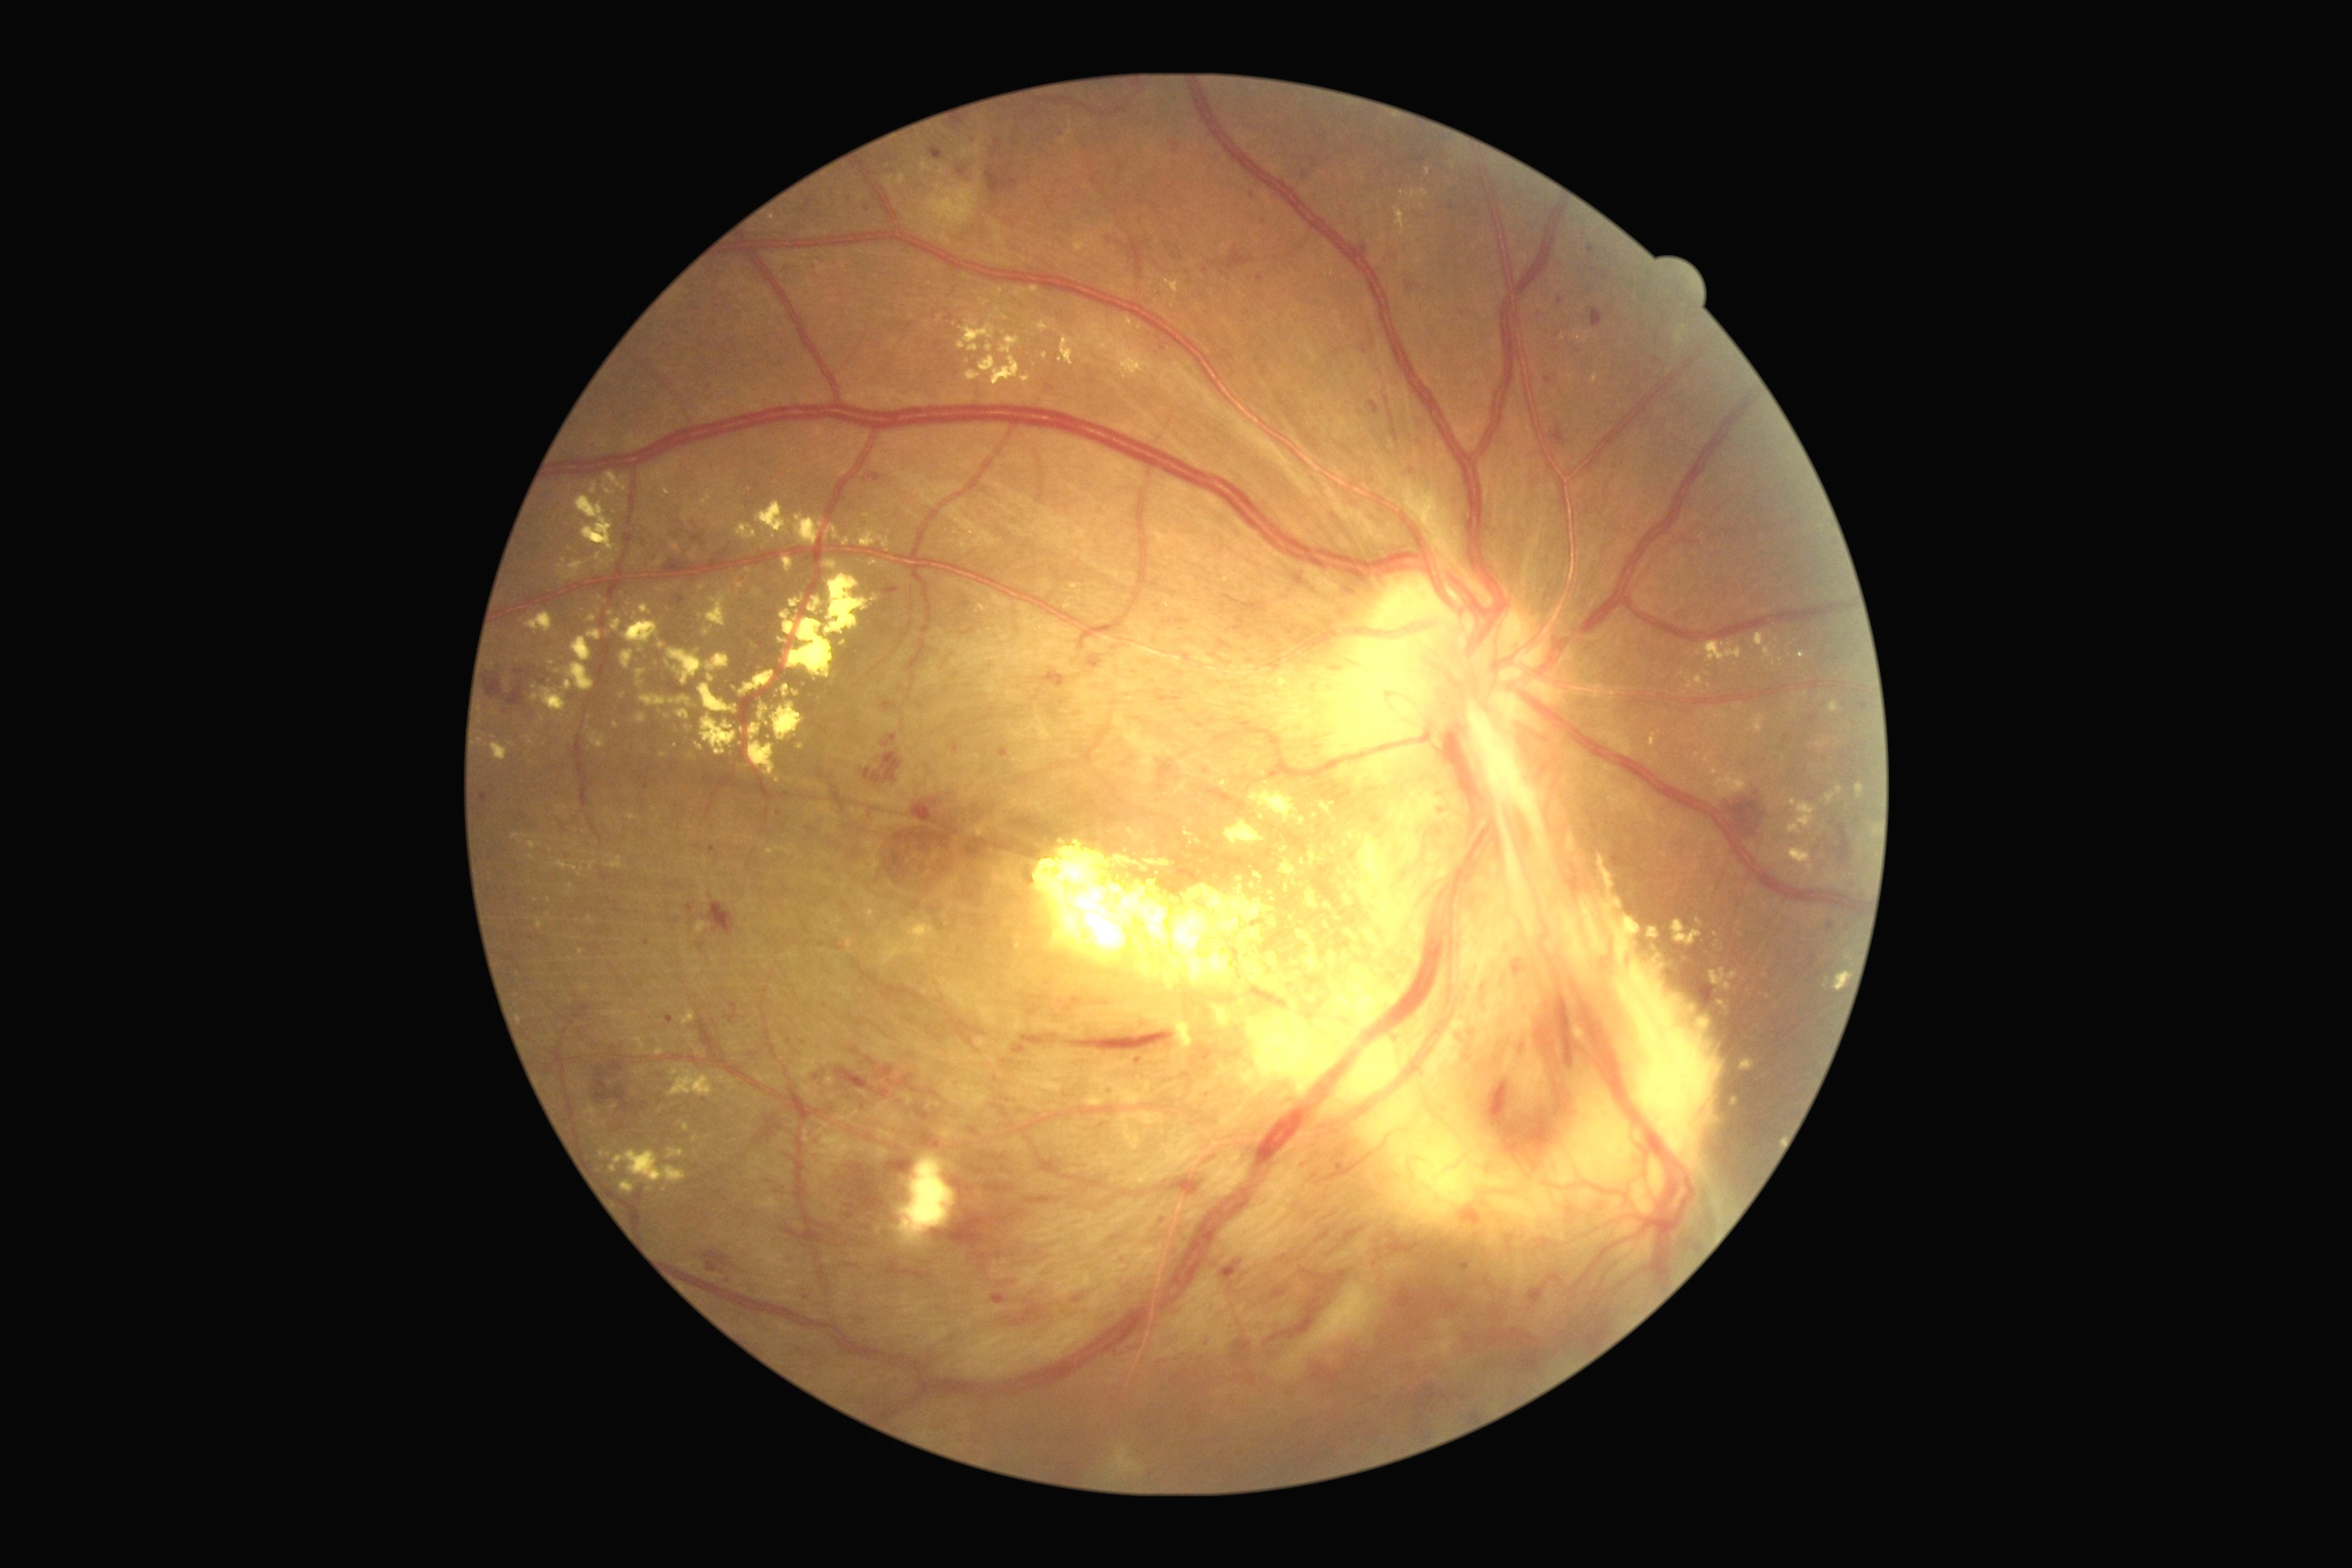

<lesions partial="true">
  <dr_grade>4</dr_grade>
  <ex partial="true">[701, 716, 738, 756], [640, 694, 667, 707], [1146, 861, 1171, 867], [897, 1153, 957, 1246], [1268, 954, 1279, 968], [1834, 972, 1848, 992], [1754, 716, 1765, 734], [554, 861, 583, 877], [1788, 799, 1816, 836], [1591, 375, 1600, 384], [997, 288, 1004, 297], [1694, 752, 1701, 760], [977, 603, 988, 612], [612, 723, 620, 729]</ex>
  <ex_small>x=768 y=725, x=1346 y=898, x=1271 y=894, x=1045 y=356, x=622 y=697</ex_small>
  <he partial="true">[663, 554, 694, 567], [877, 587, 899, 596], [814, 1073, 827, 1086], [1269, 1297, 1324, 1344], [1529, 1286, 1542, 1304], [701, 903, 736, 937], [1360, 240, 1373, 255], [1202, 270, 1210, 275], [879, 1088, 890, 1099], [480, 794, 489, 805], [1373, 1230, 1422, 1264], [642, 536, 649, 545], [865, 769, 870, 779], [1021, 1034, 1061, 1046], [1415, 1422, 1435, 1438], [836, 1068, 876, 1093], [1012, 1304, 1043, 1328], [1014, 1044, 1026, 1055], [705, 1251, 732, 1273]</he>
  <he_small>x=868 y=209</he_small>
</lesions>